Color fundus image, 45° field of view:
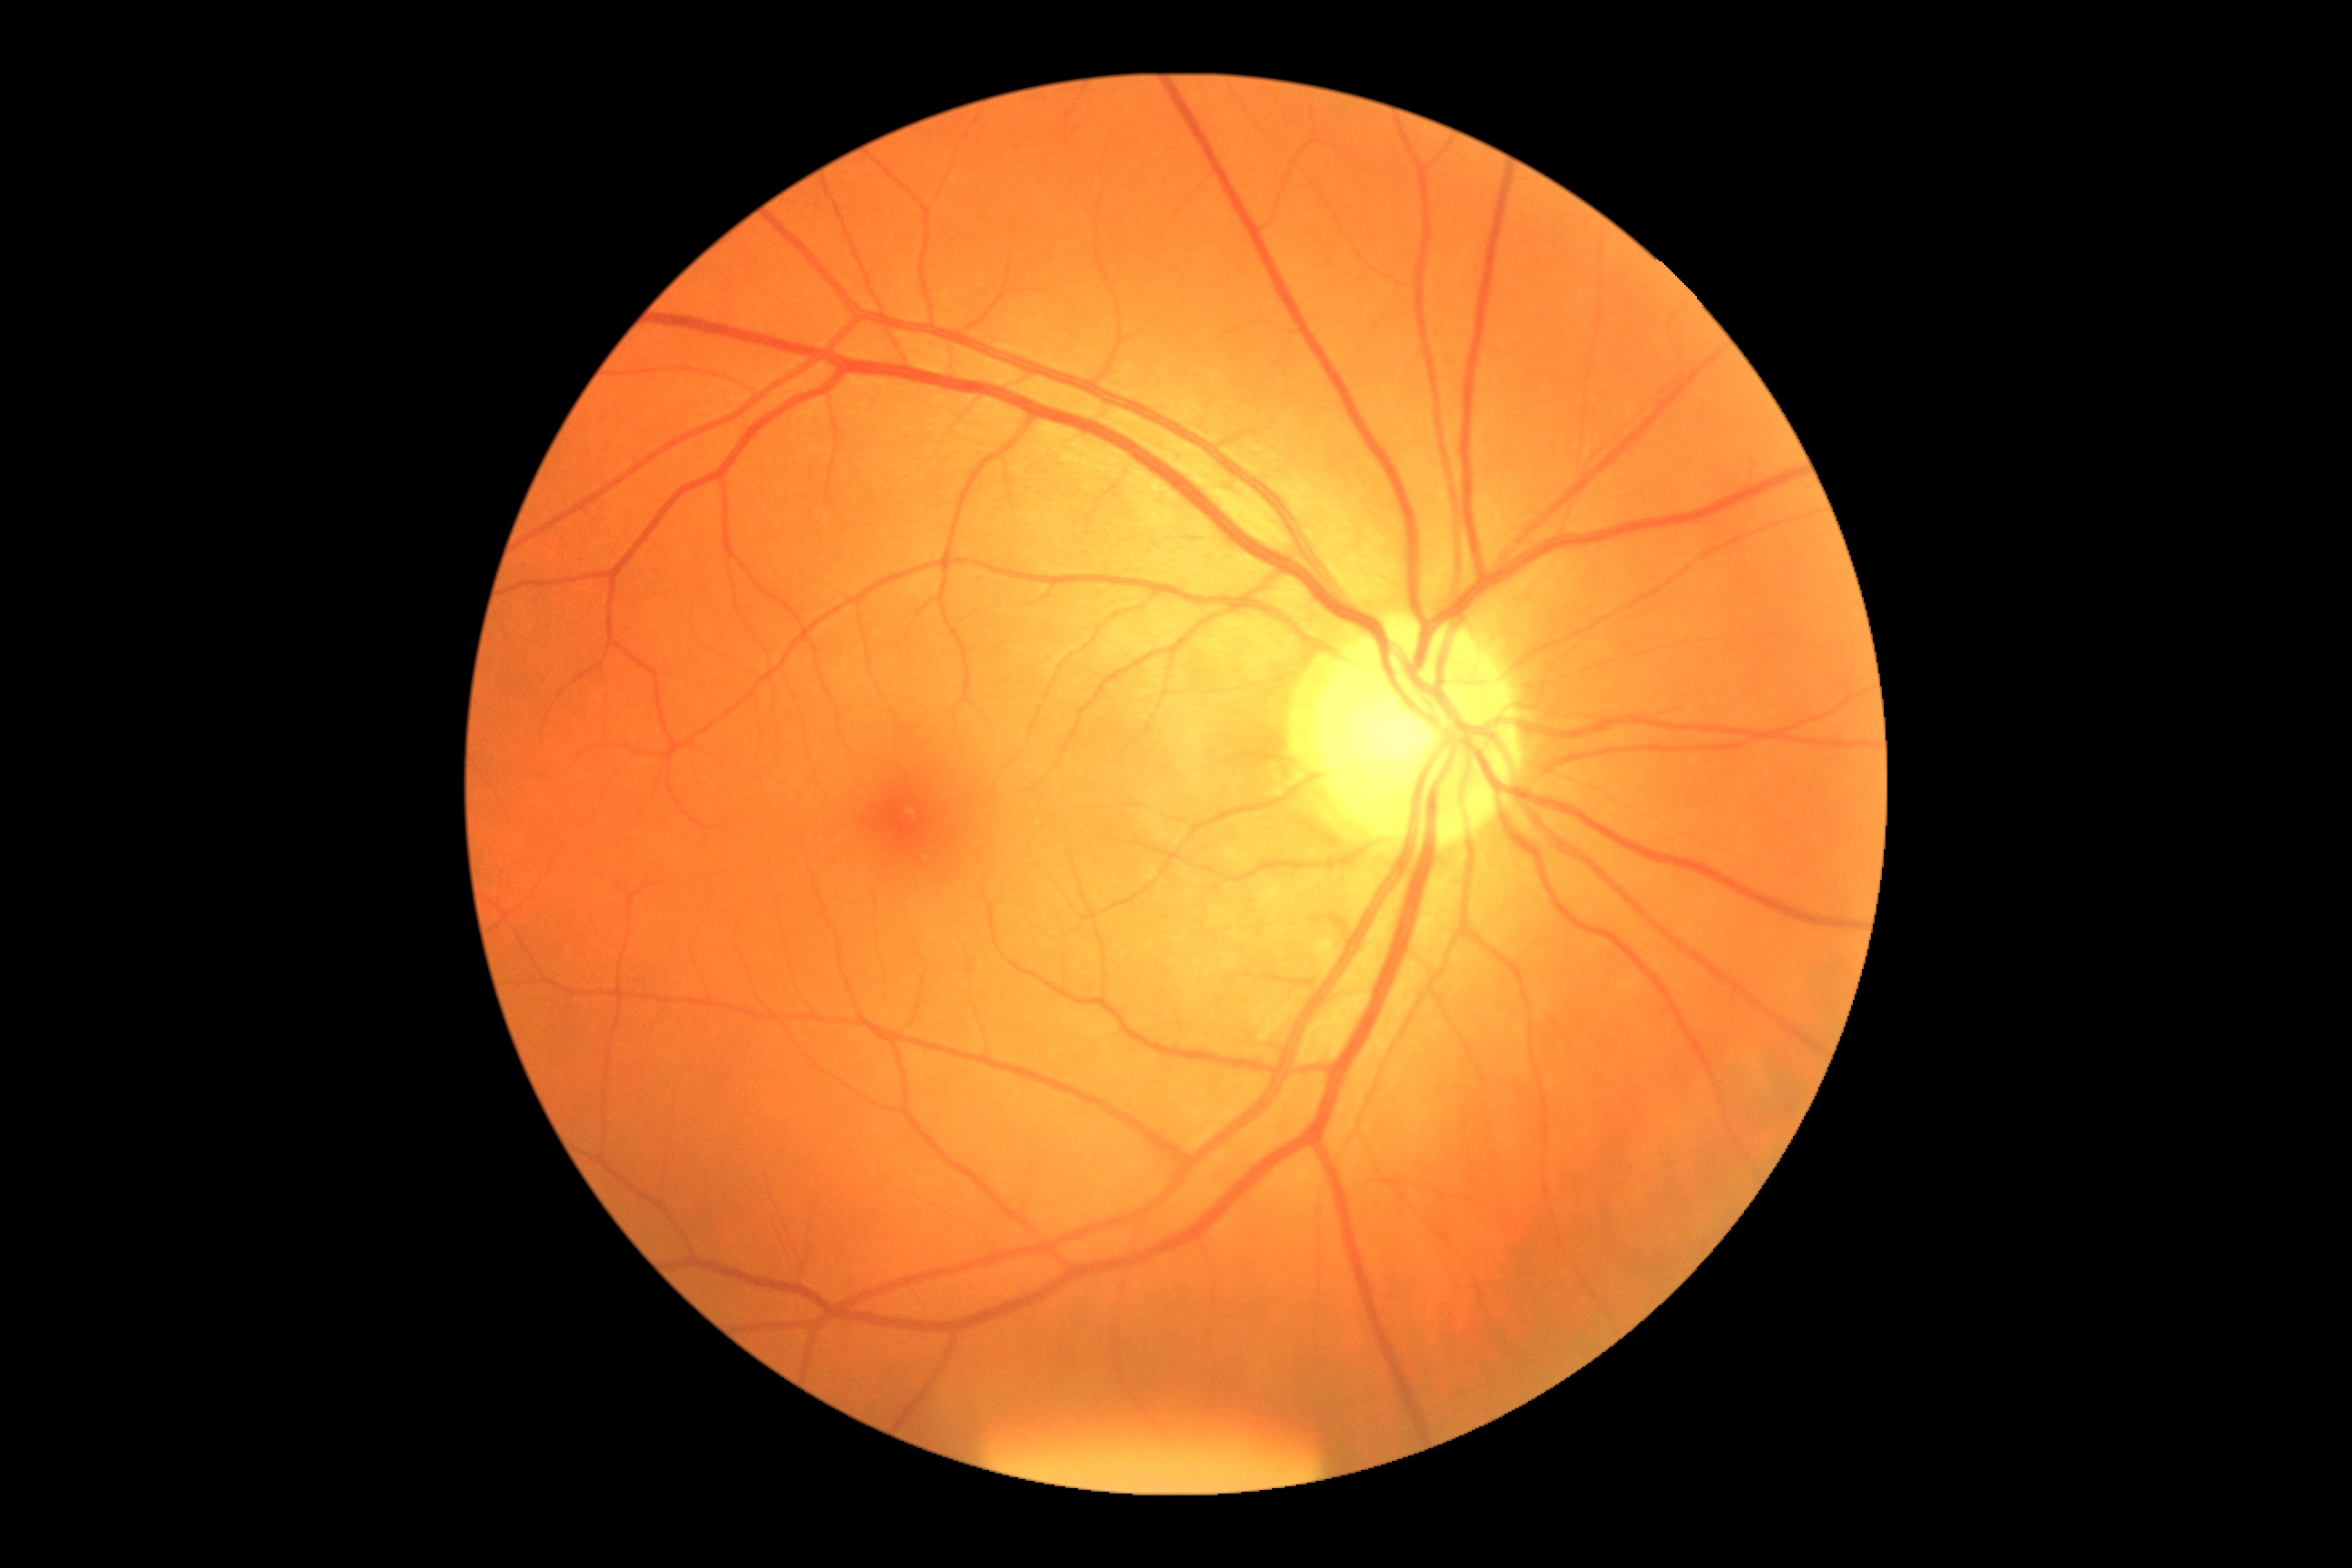

dr_grade: grade 0 (no apparent retinopathy)
dr_impression: no apparent DR